848x848. 45° field of view — 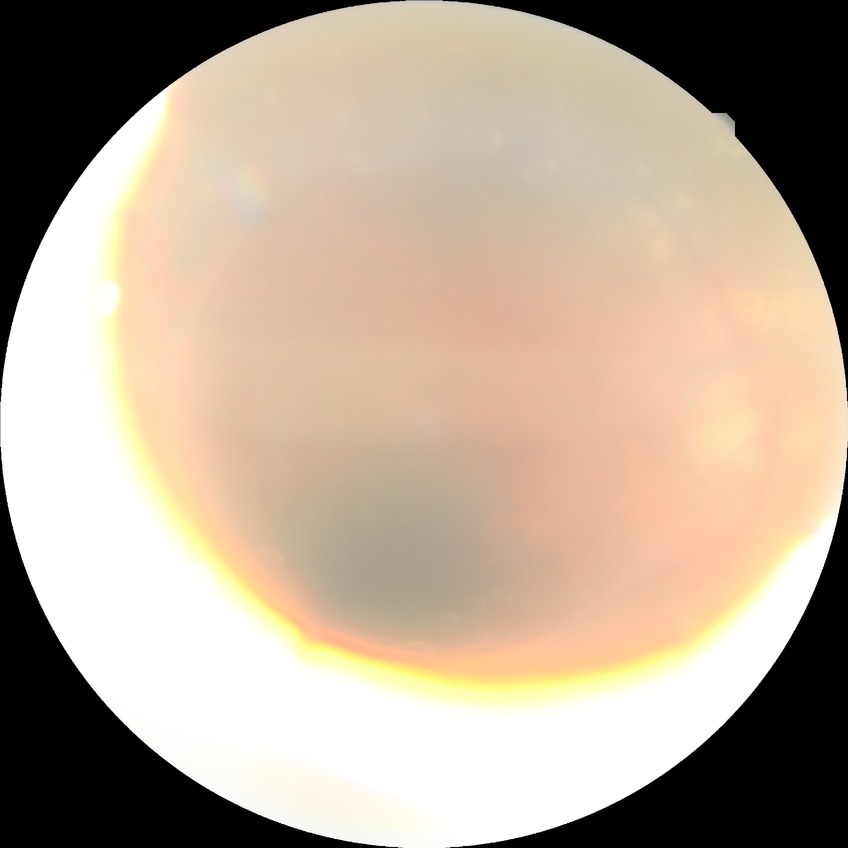

Davis stage: PDR.